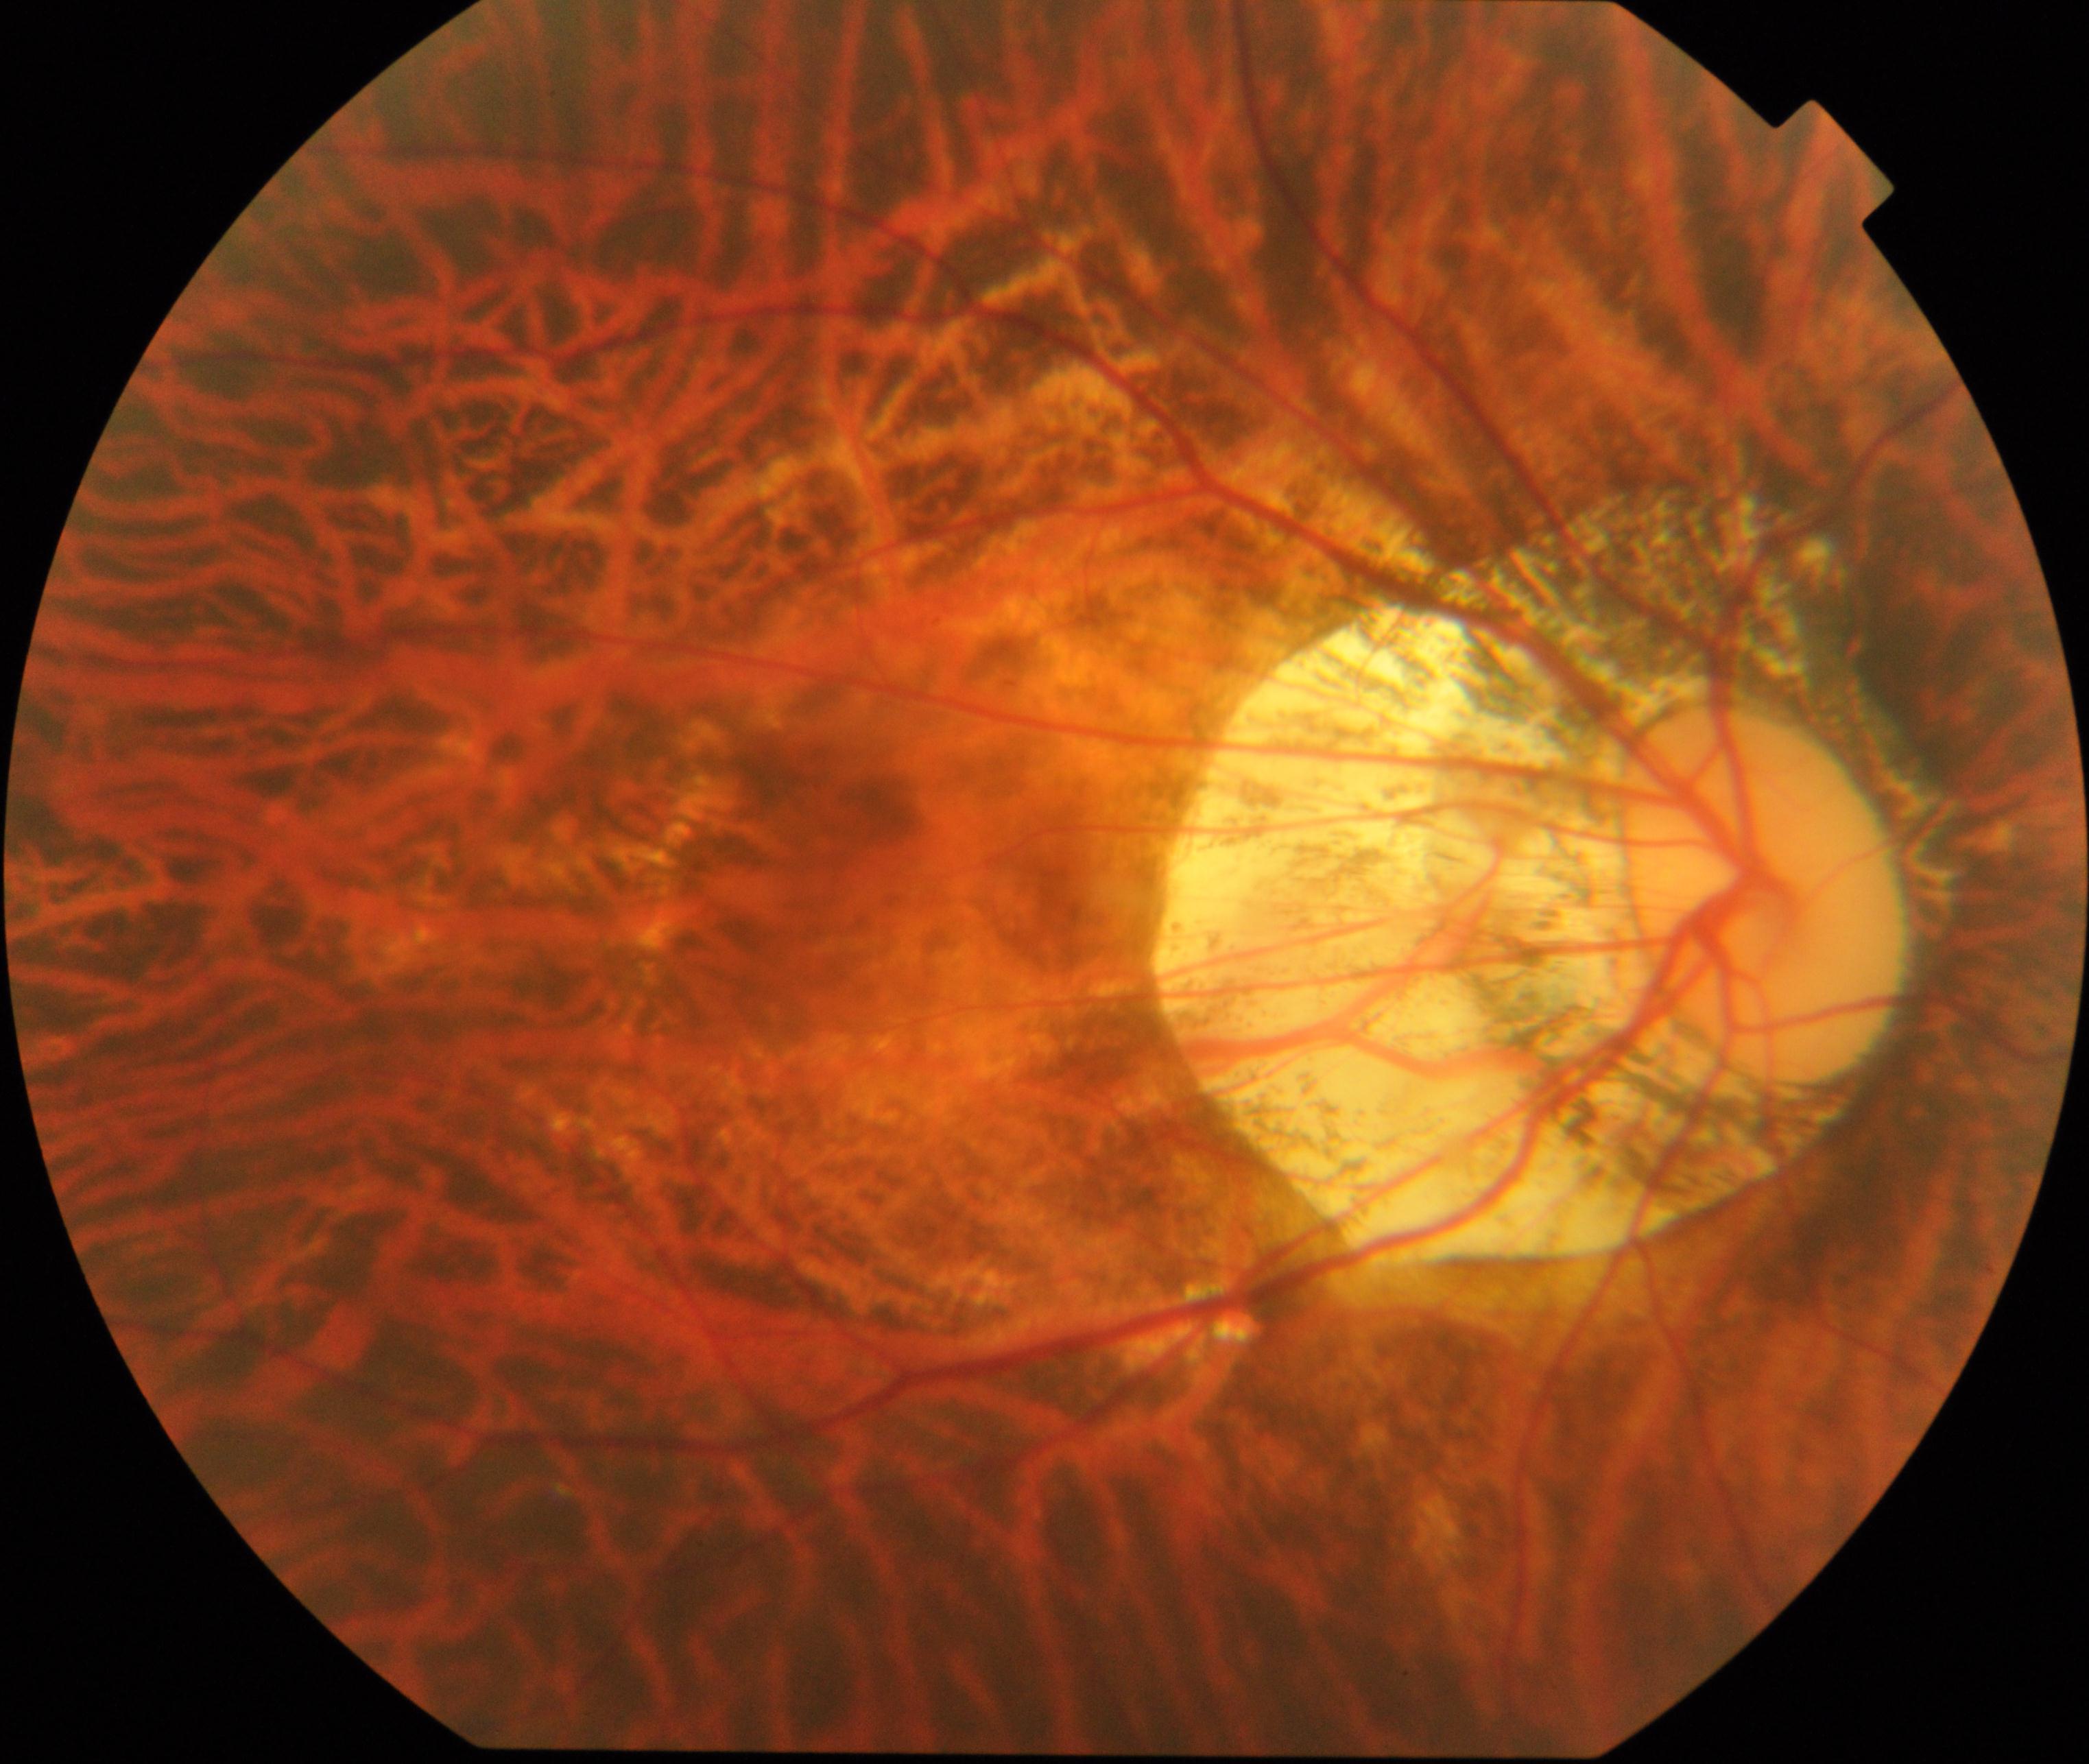
Diagnosis: pathological myopia.